2048x1536:
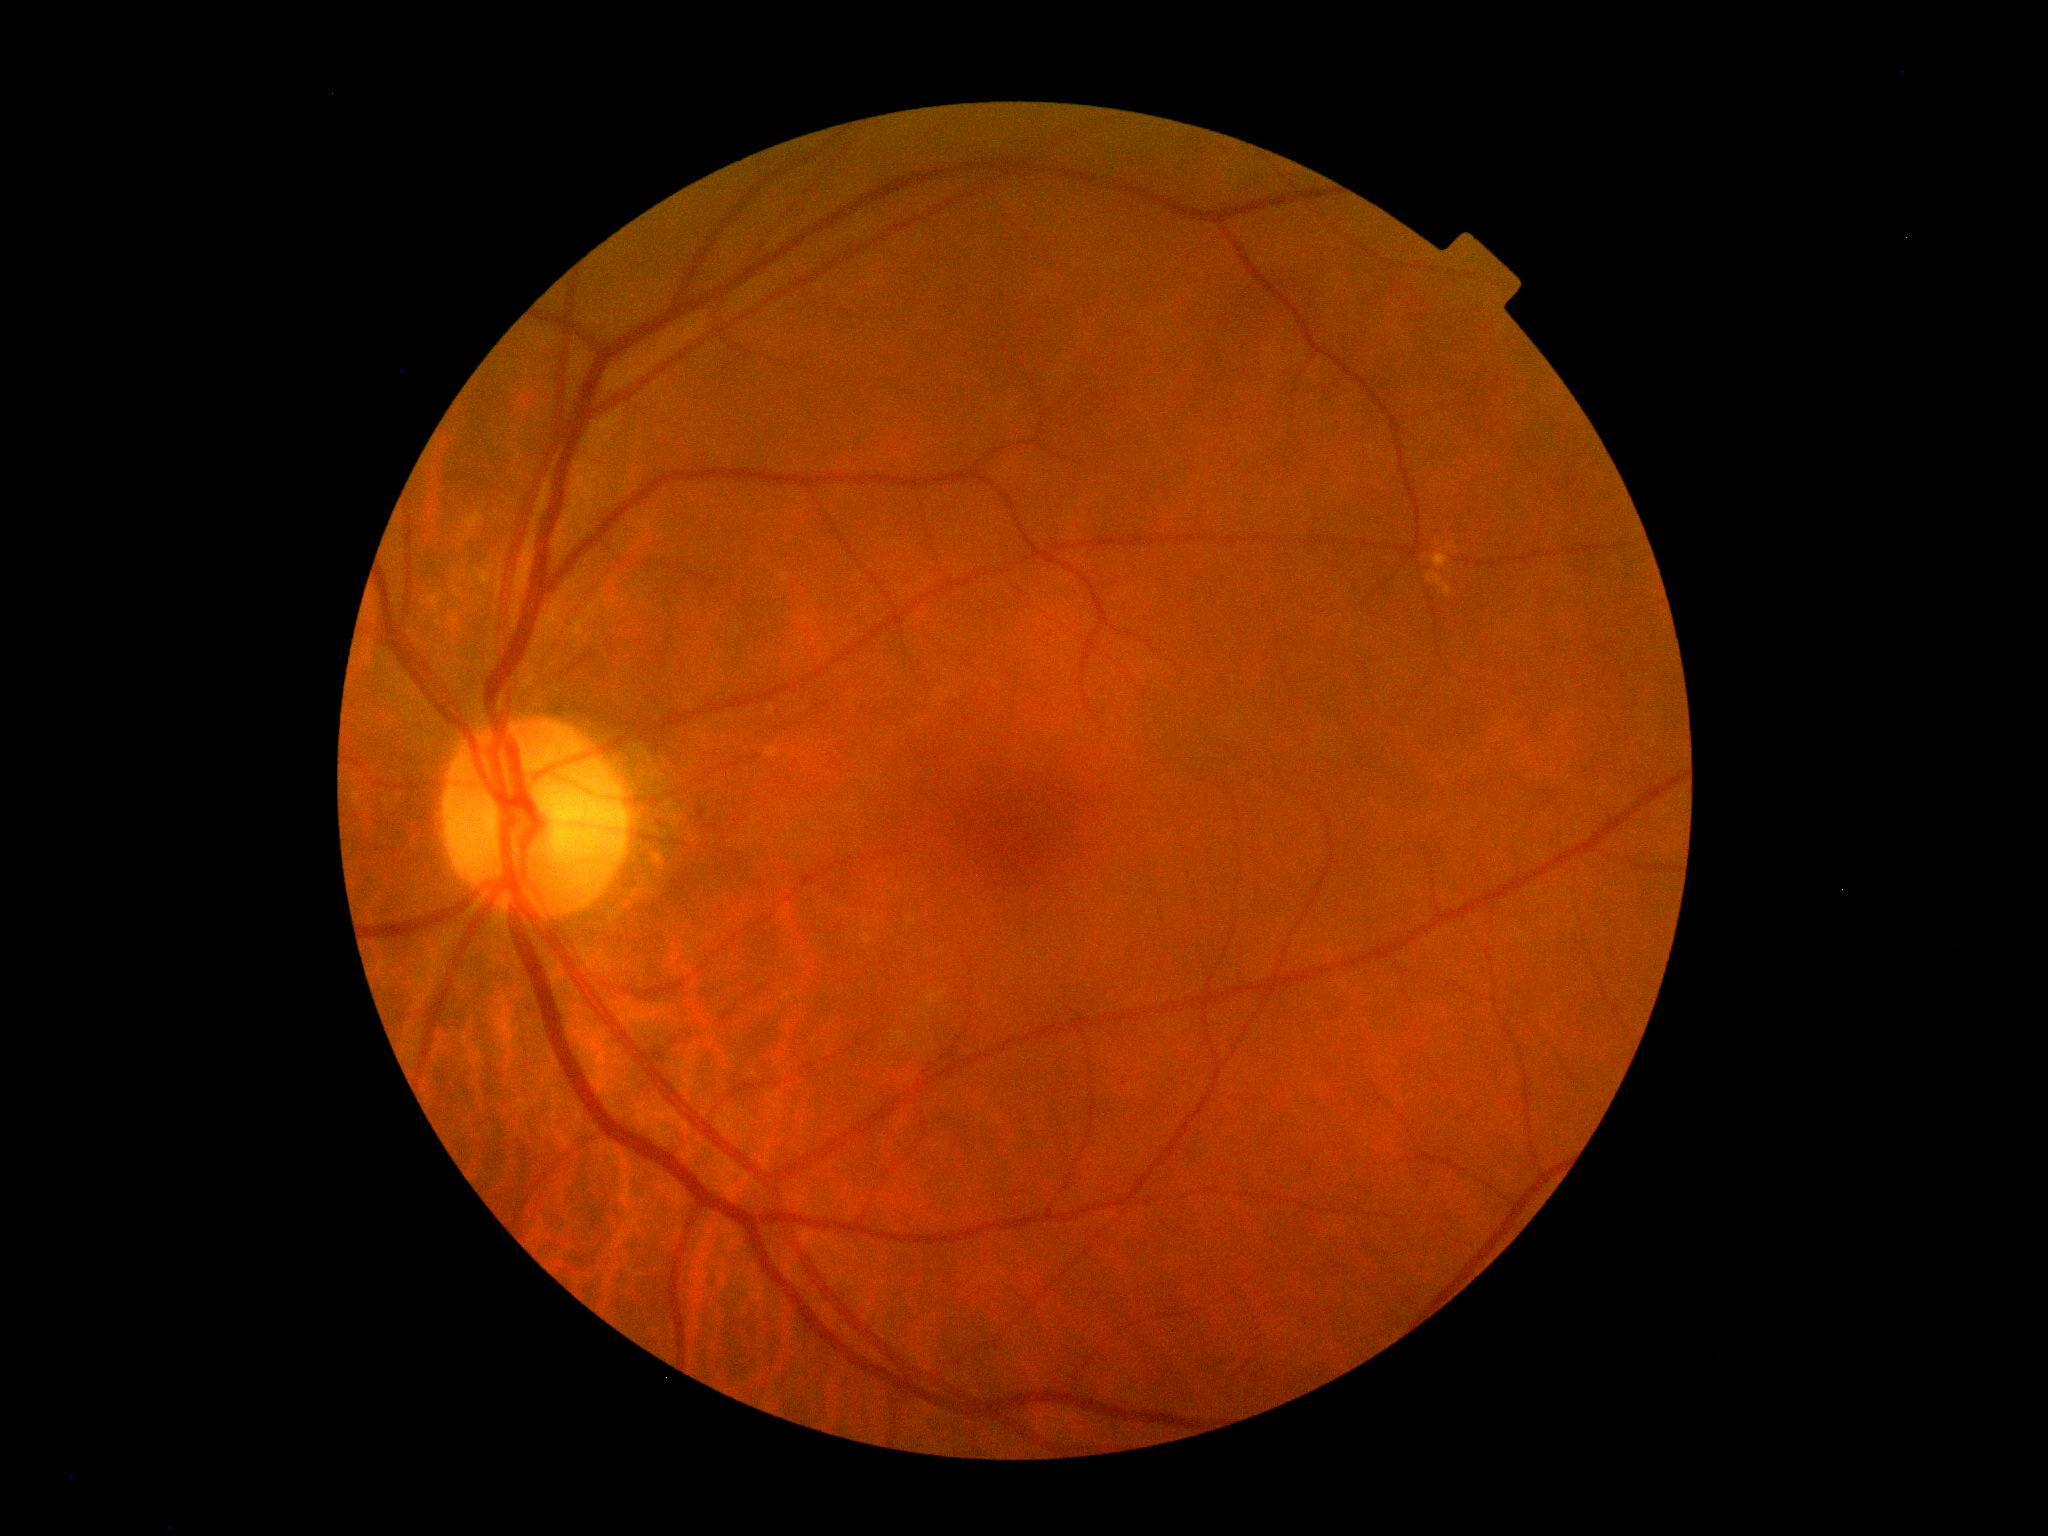 {"dr_grade": "no apparent retinopathy (grade 0)"}